Color fundus image; 848 x 848 pixels; 45-degree field of view: 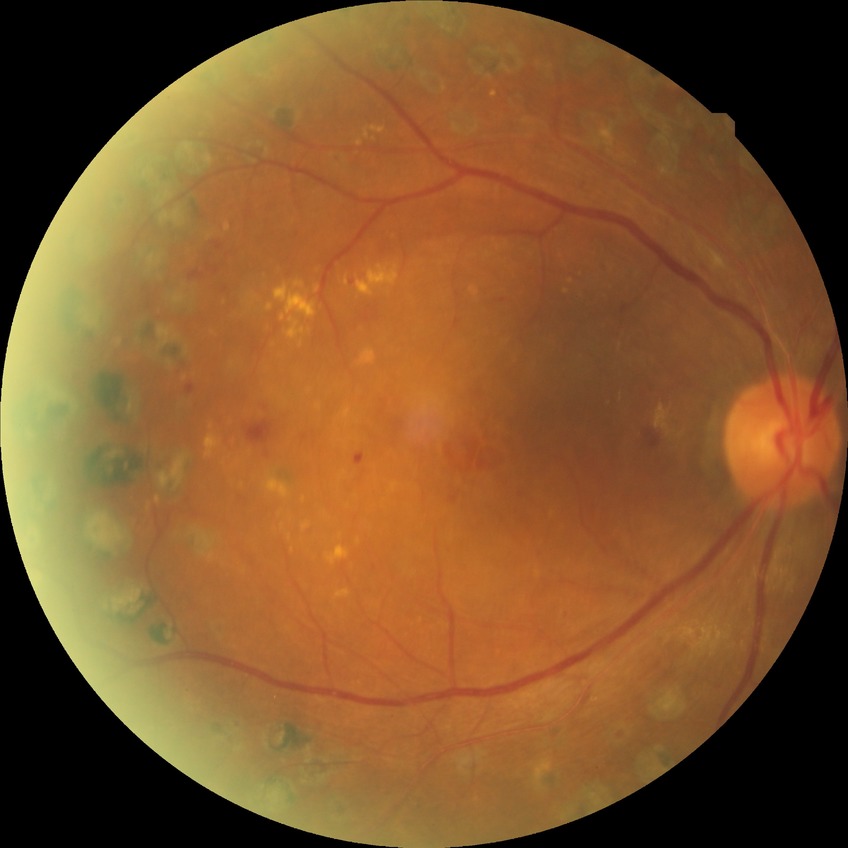

  davis_grade: PDR (proliferative diabetic retinopathy)